Wide-field fundus photograph of an infant · captured with the Clarity RetCam 3 (130° field of view) · 640 x 480 pixels: 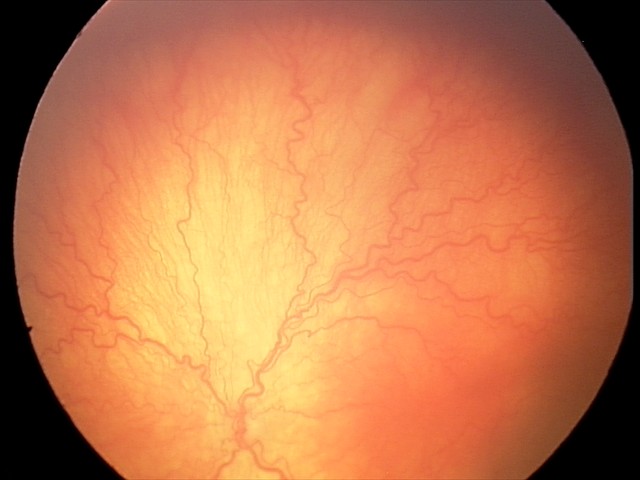 Plus disease present. Series diagnosed as aggressive retinopathy of prematurity.